Retinal fundus photograph · 2352x1568px · FOV: 45 degrees: 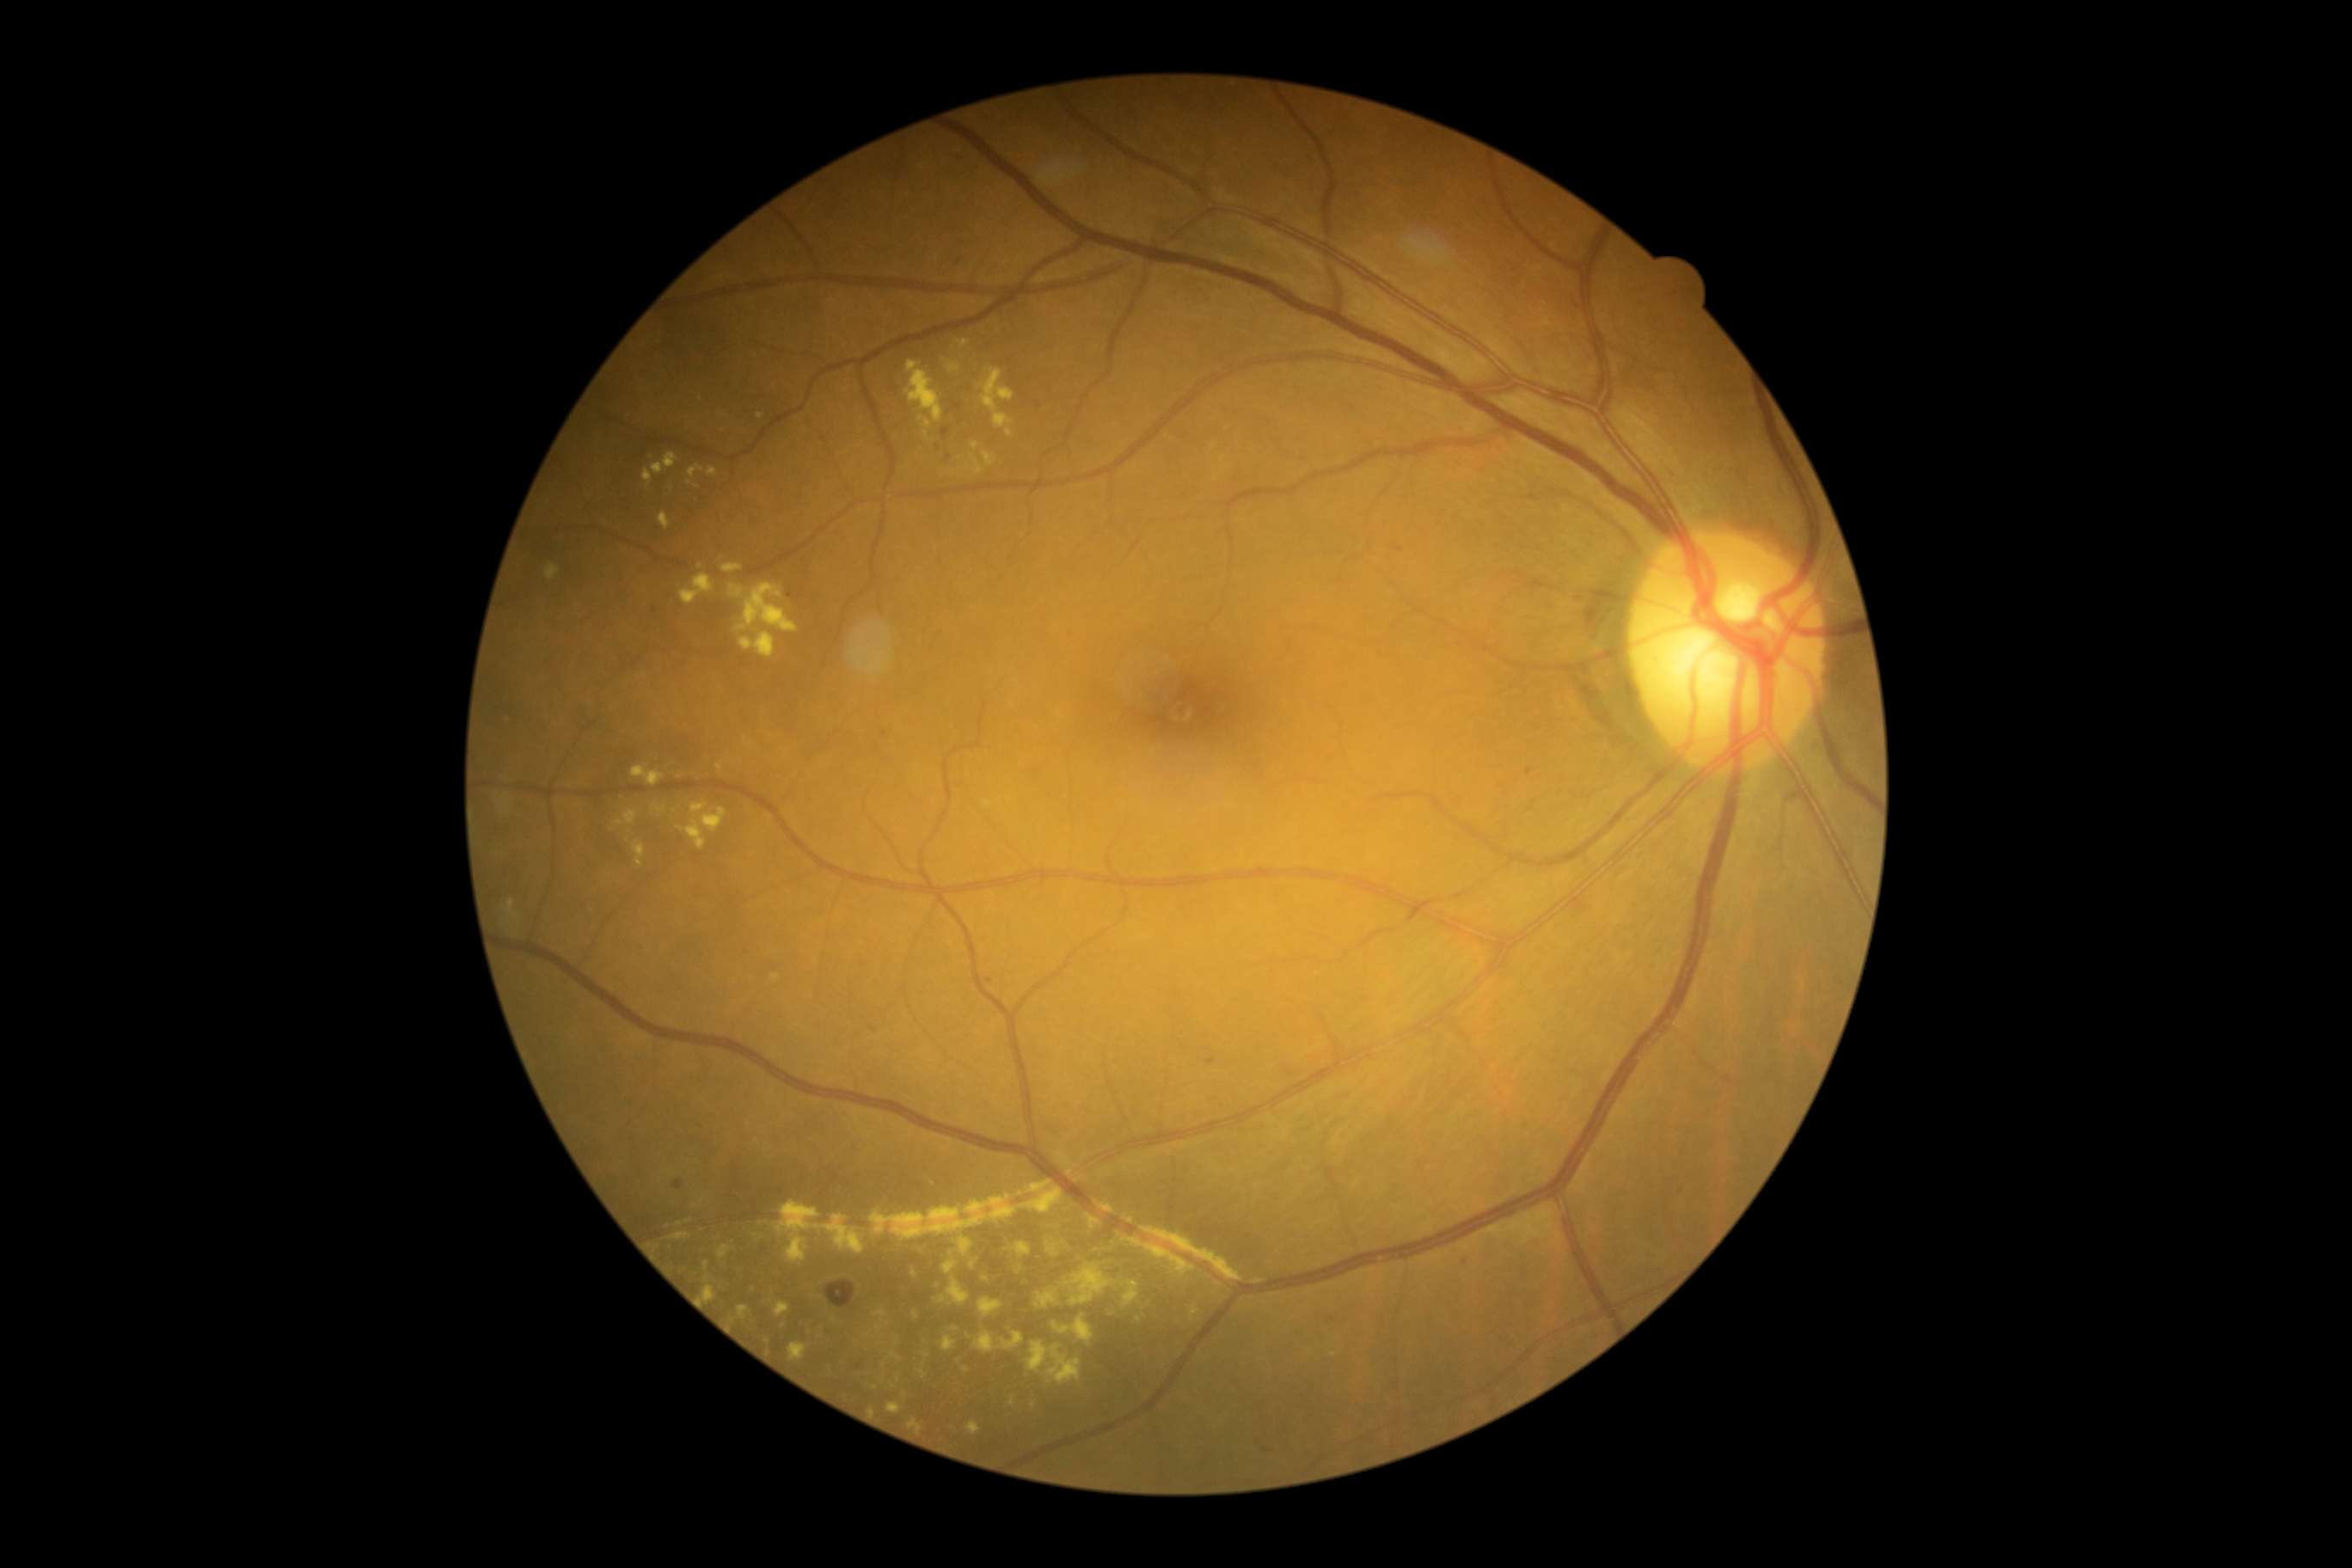
Diabetic retinopathy grade is moderate NPDR (2). Hard exudates include 943:1259:959:1275; 919:1369:926:1378; 1005:1242:1032:1259; 940:1335:957:1352; 775:1201:866:1263; 1191:1306:1201:1320; 1015:1265:1024:1273; 952:1326:960:1332; 740:632:776:658; 1063:1263:1117:1306; 659:511:671:530; 919:415:933:429; 1058:1155:1070:1163. Small hard exudates near <point>1217, 1283</point>; <point>1056, 1228</point>; <point>973, 1265</point>; <point>783, 1326</point>; <point>689, 483</point>; <point>768, 1342</point>.